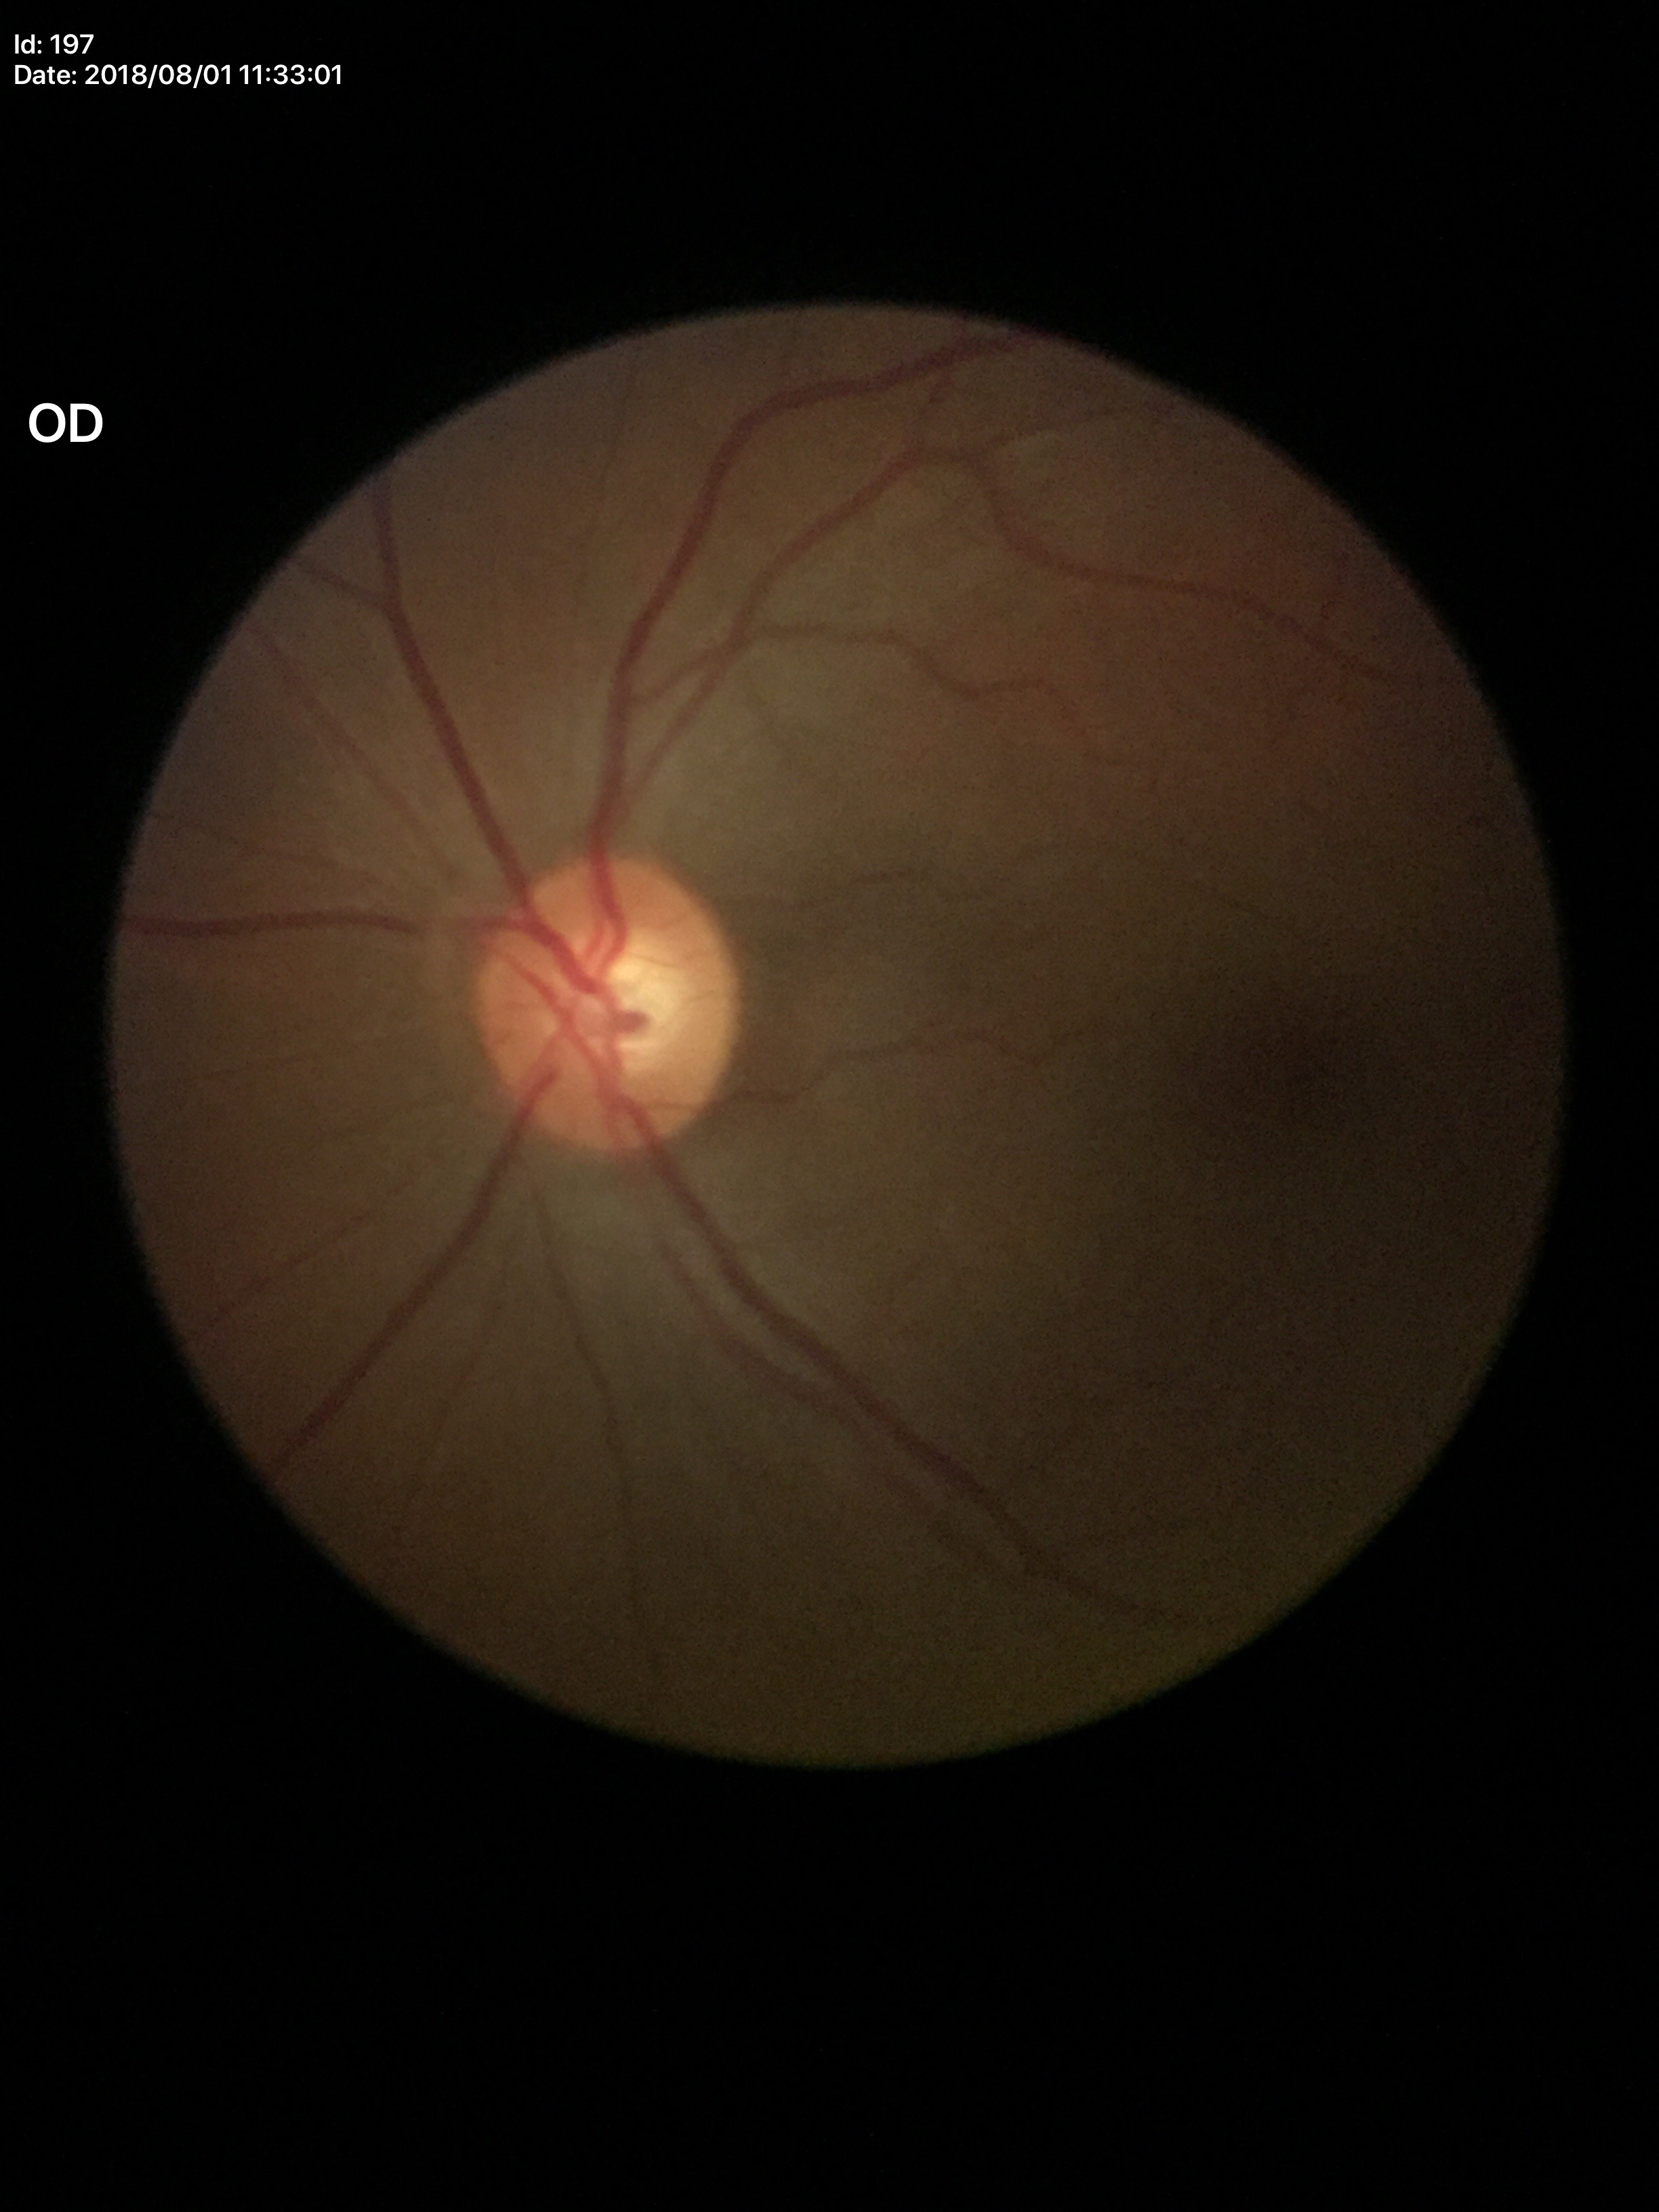
Horizontal cup-to-disc ratio (HCDR) of 0.61. Glaucoma evaluation: no suspicious findings. Vertical C/D ratio (VCDR) is 0.58.